Phoenix ICON wide-field infant fundus image · 1240x1240.
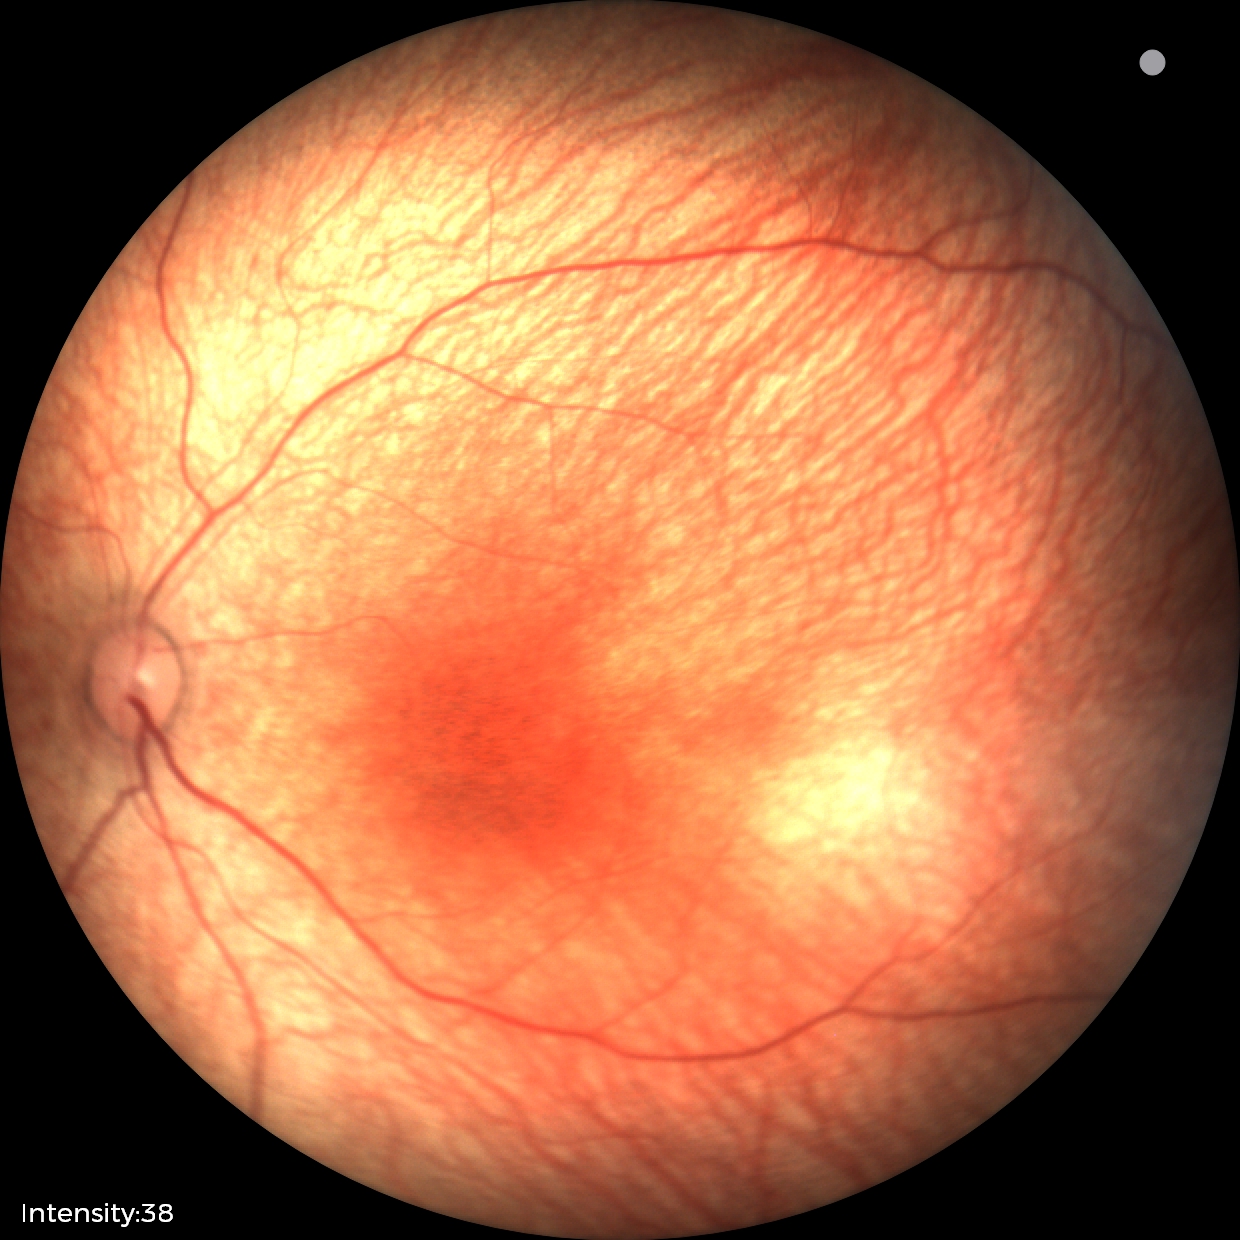
Q: What is the screening diagnosis?
A: physiological retinal finding